Retinal fundus photograph, 848x848.
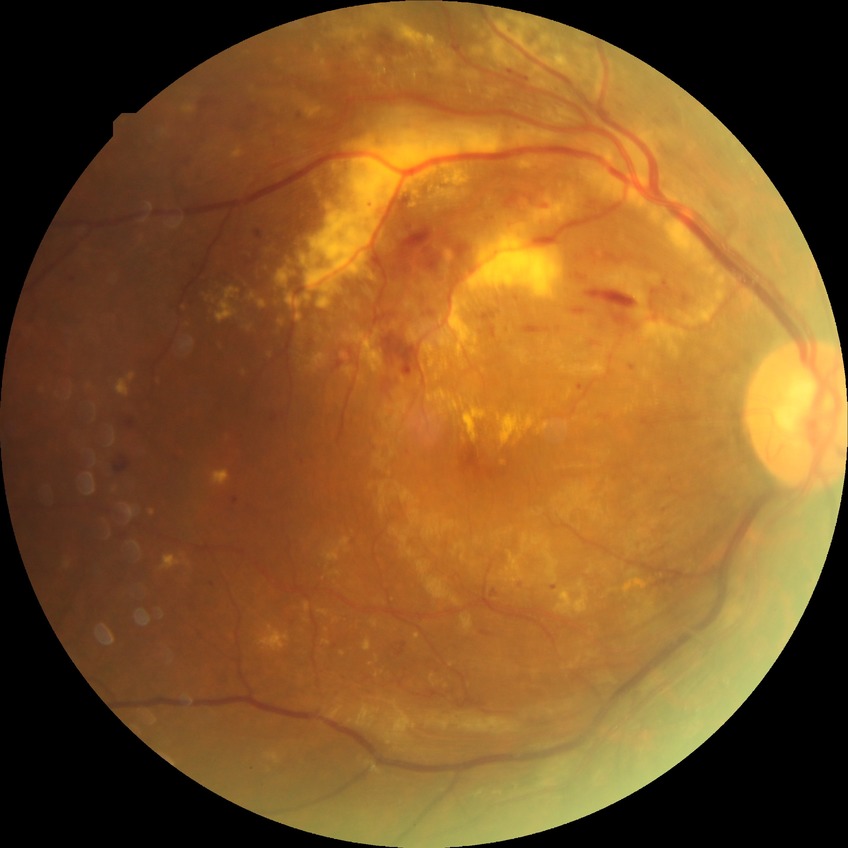
proliferative_class: non-proliferative diabetic retinopathy
davis_grade: PPDR (pre-proliferative diabetic retinopathy)